NIDEK AFC-230; image size 848x848: 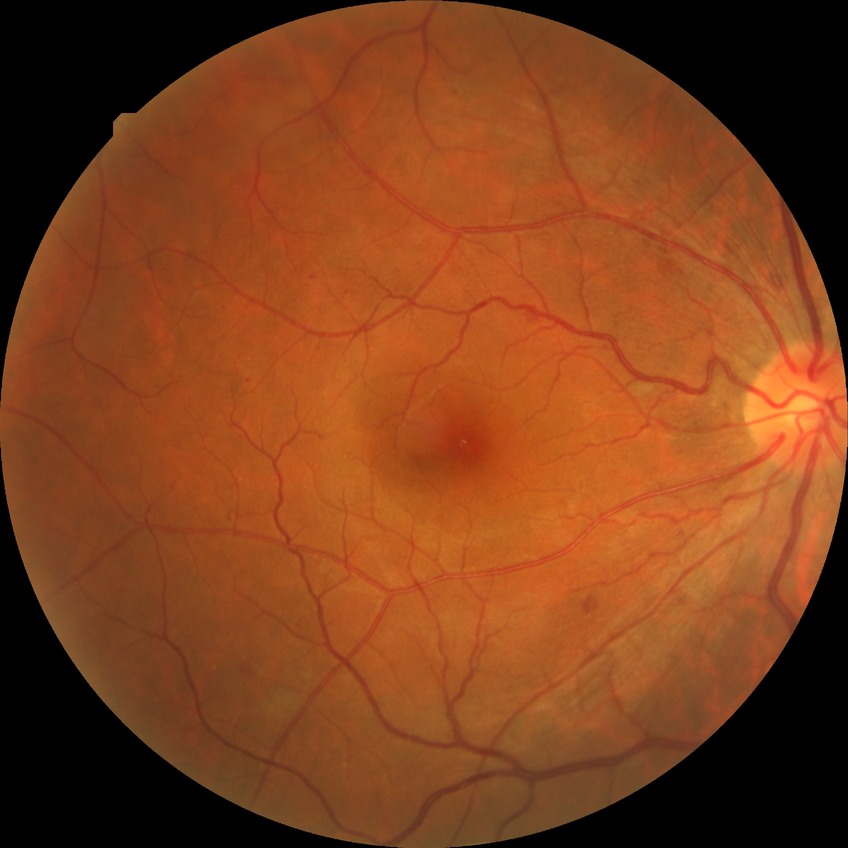 Diabetic retinopathy severity: simple diabetic retinopathy.